Portable fundus photograph; 60° FOV — 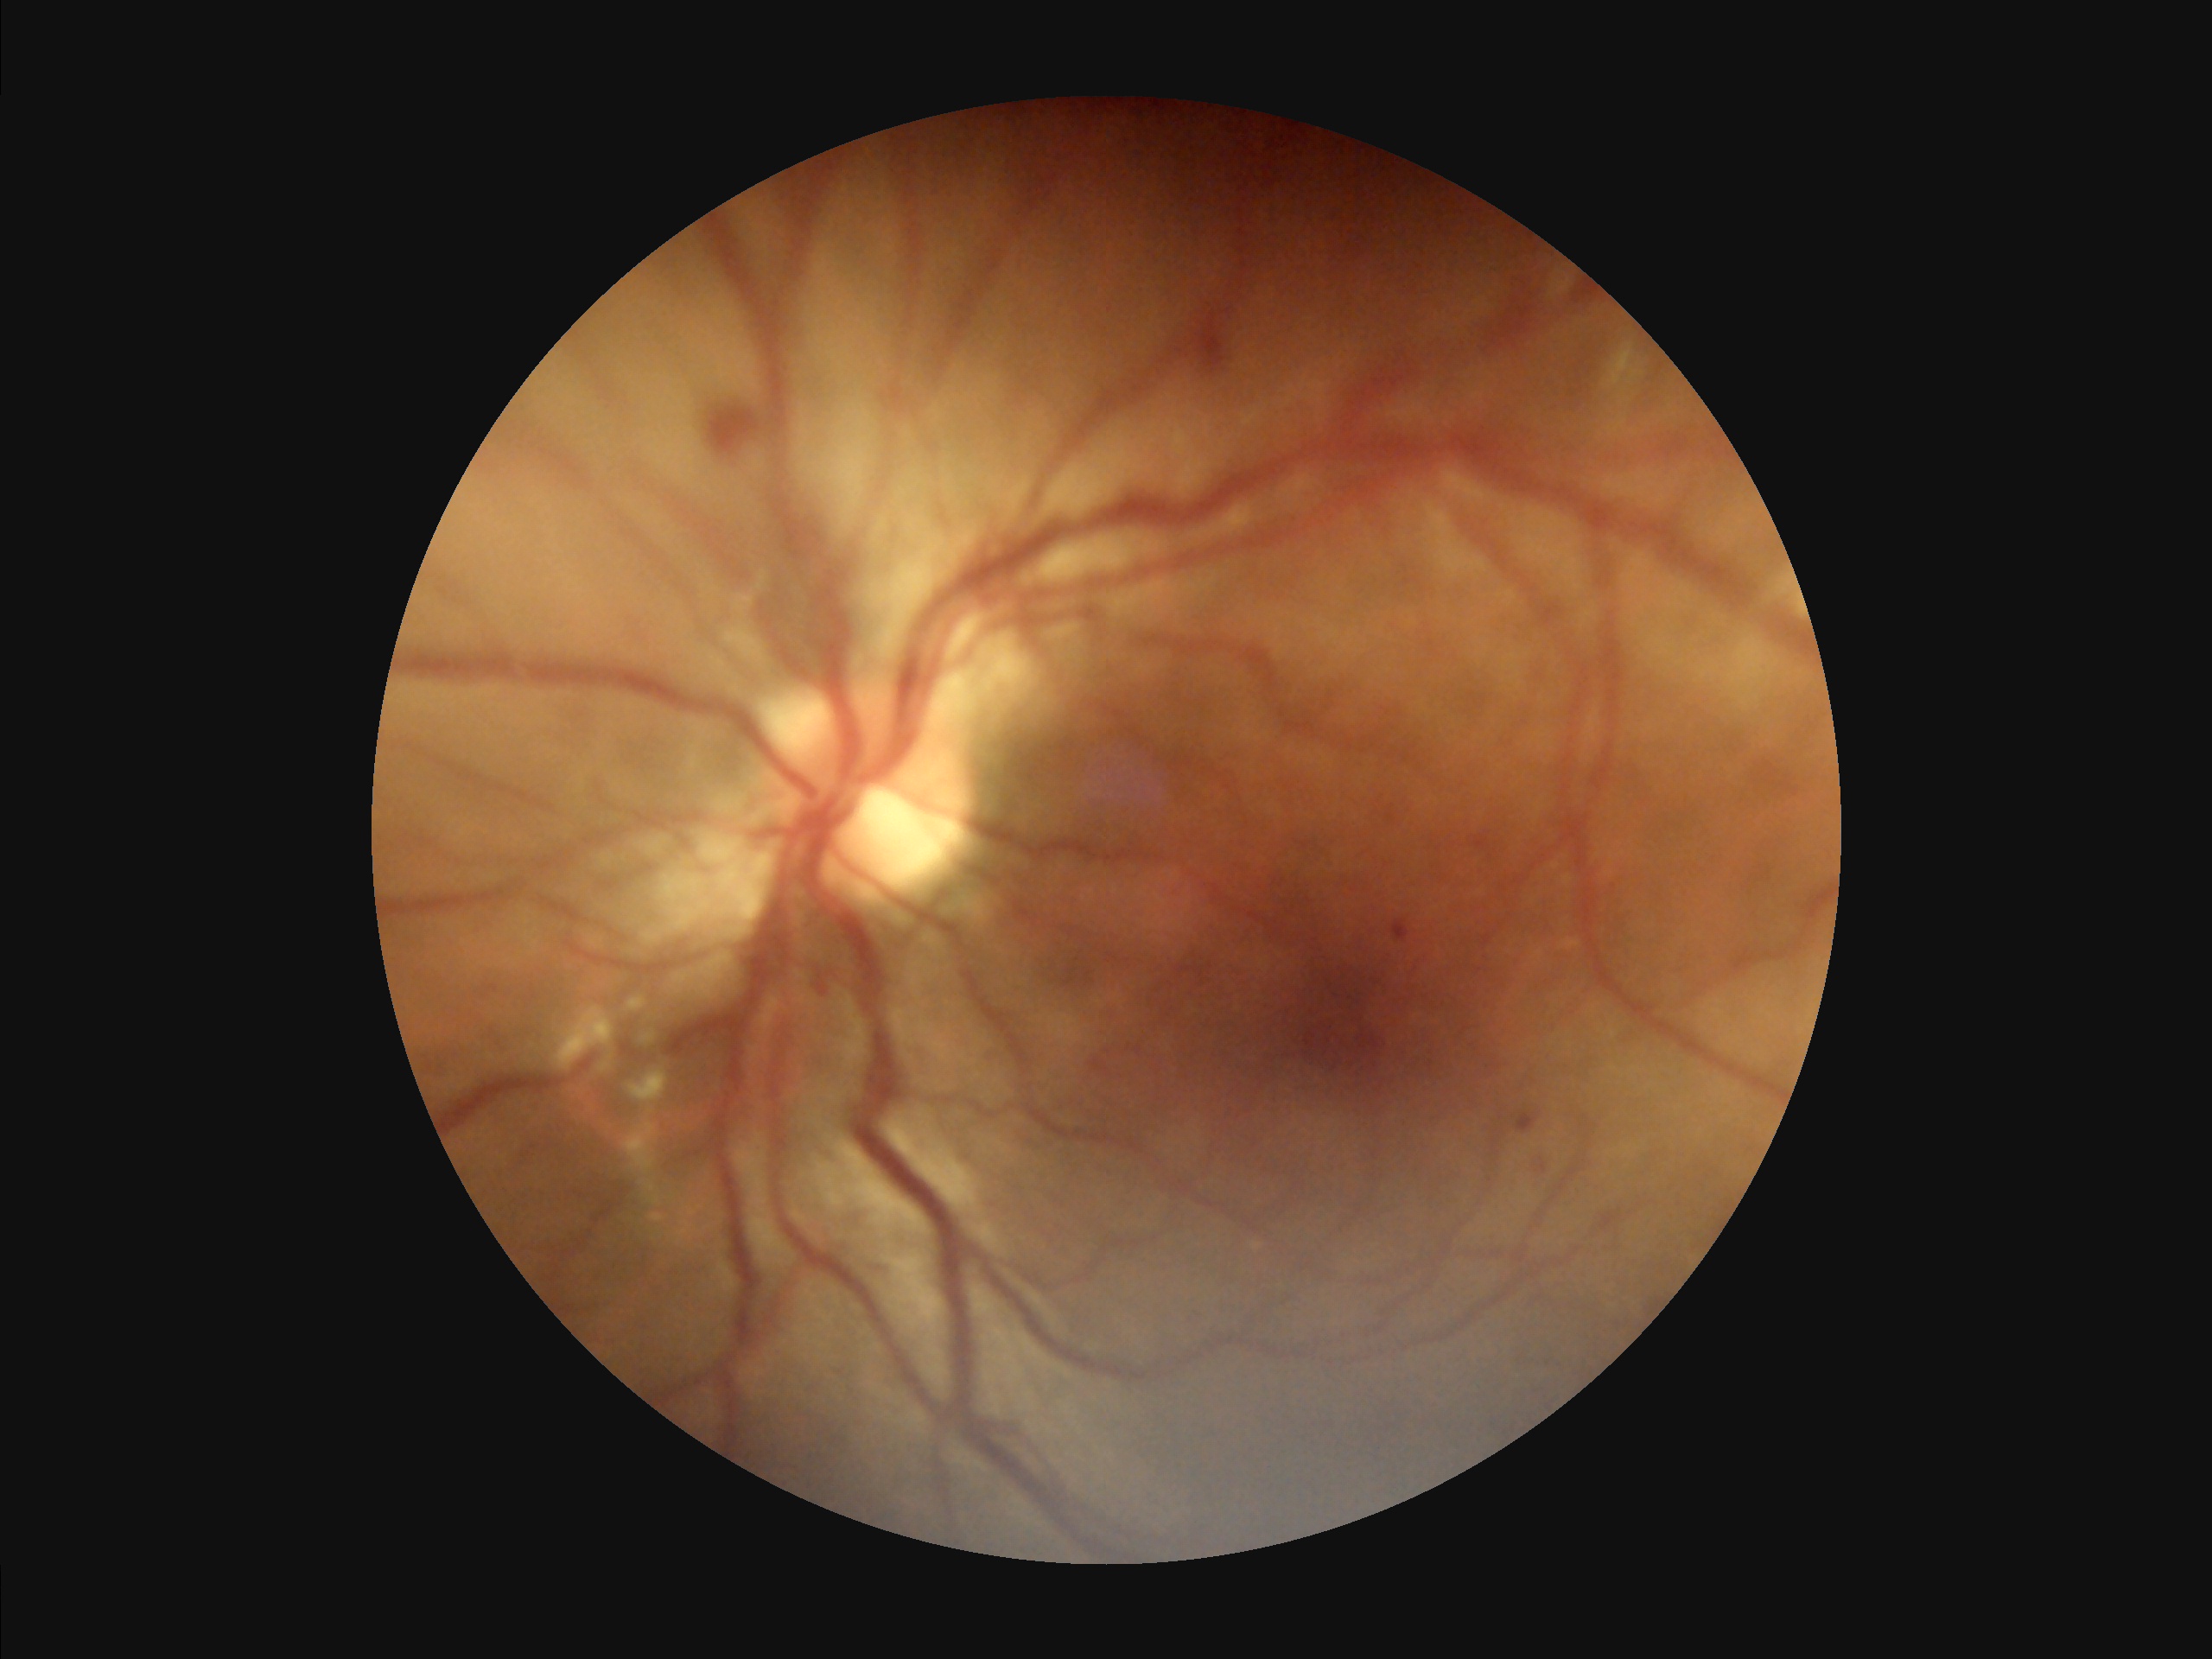 Illumination and color balance are good. The image is blurry. Adequate contrast for distinguishing structures. Image quality is suboptimal.